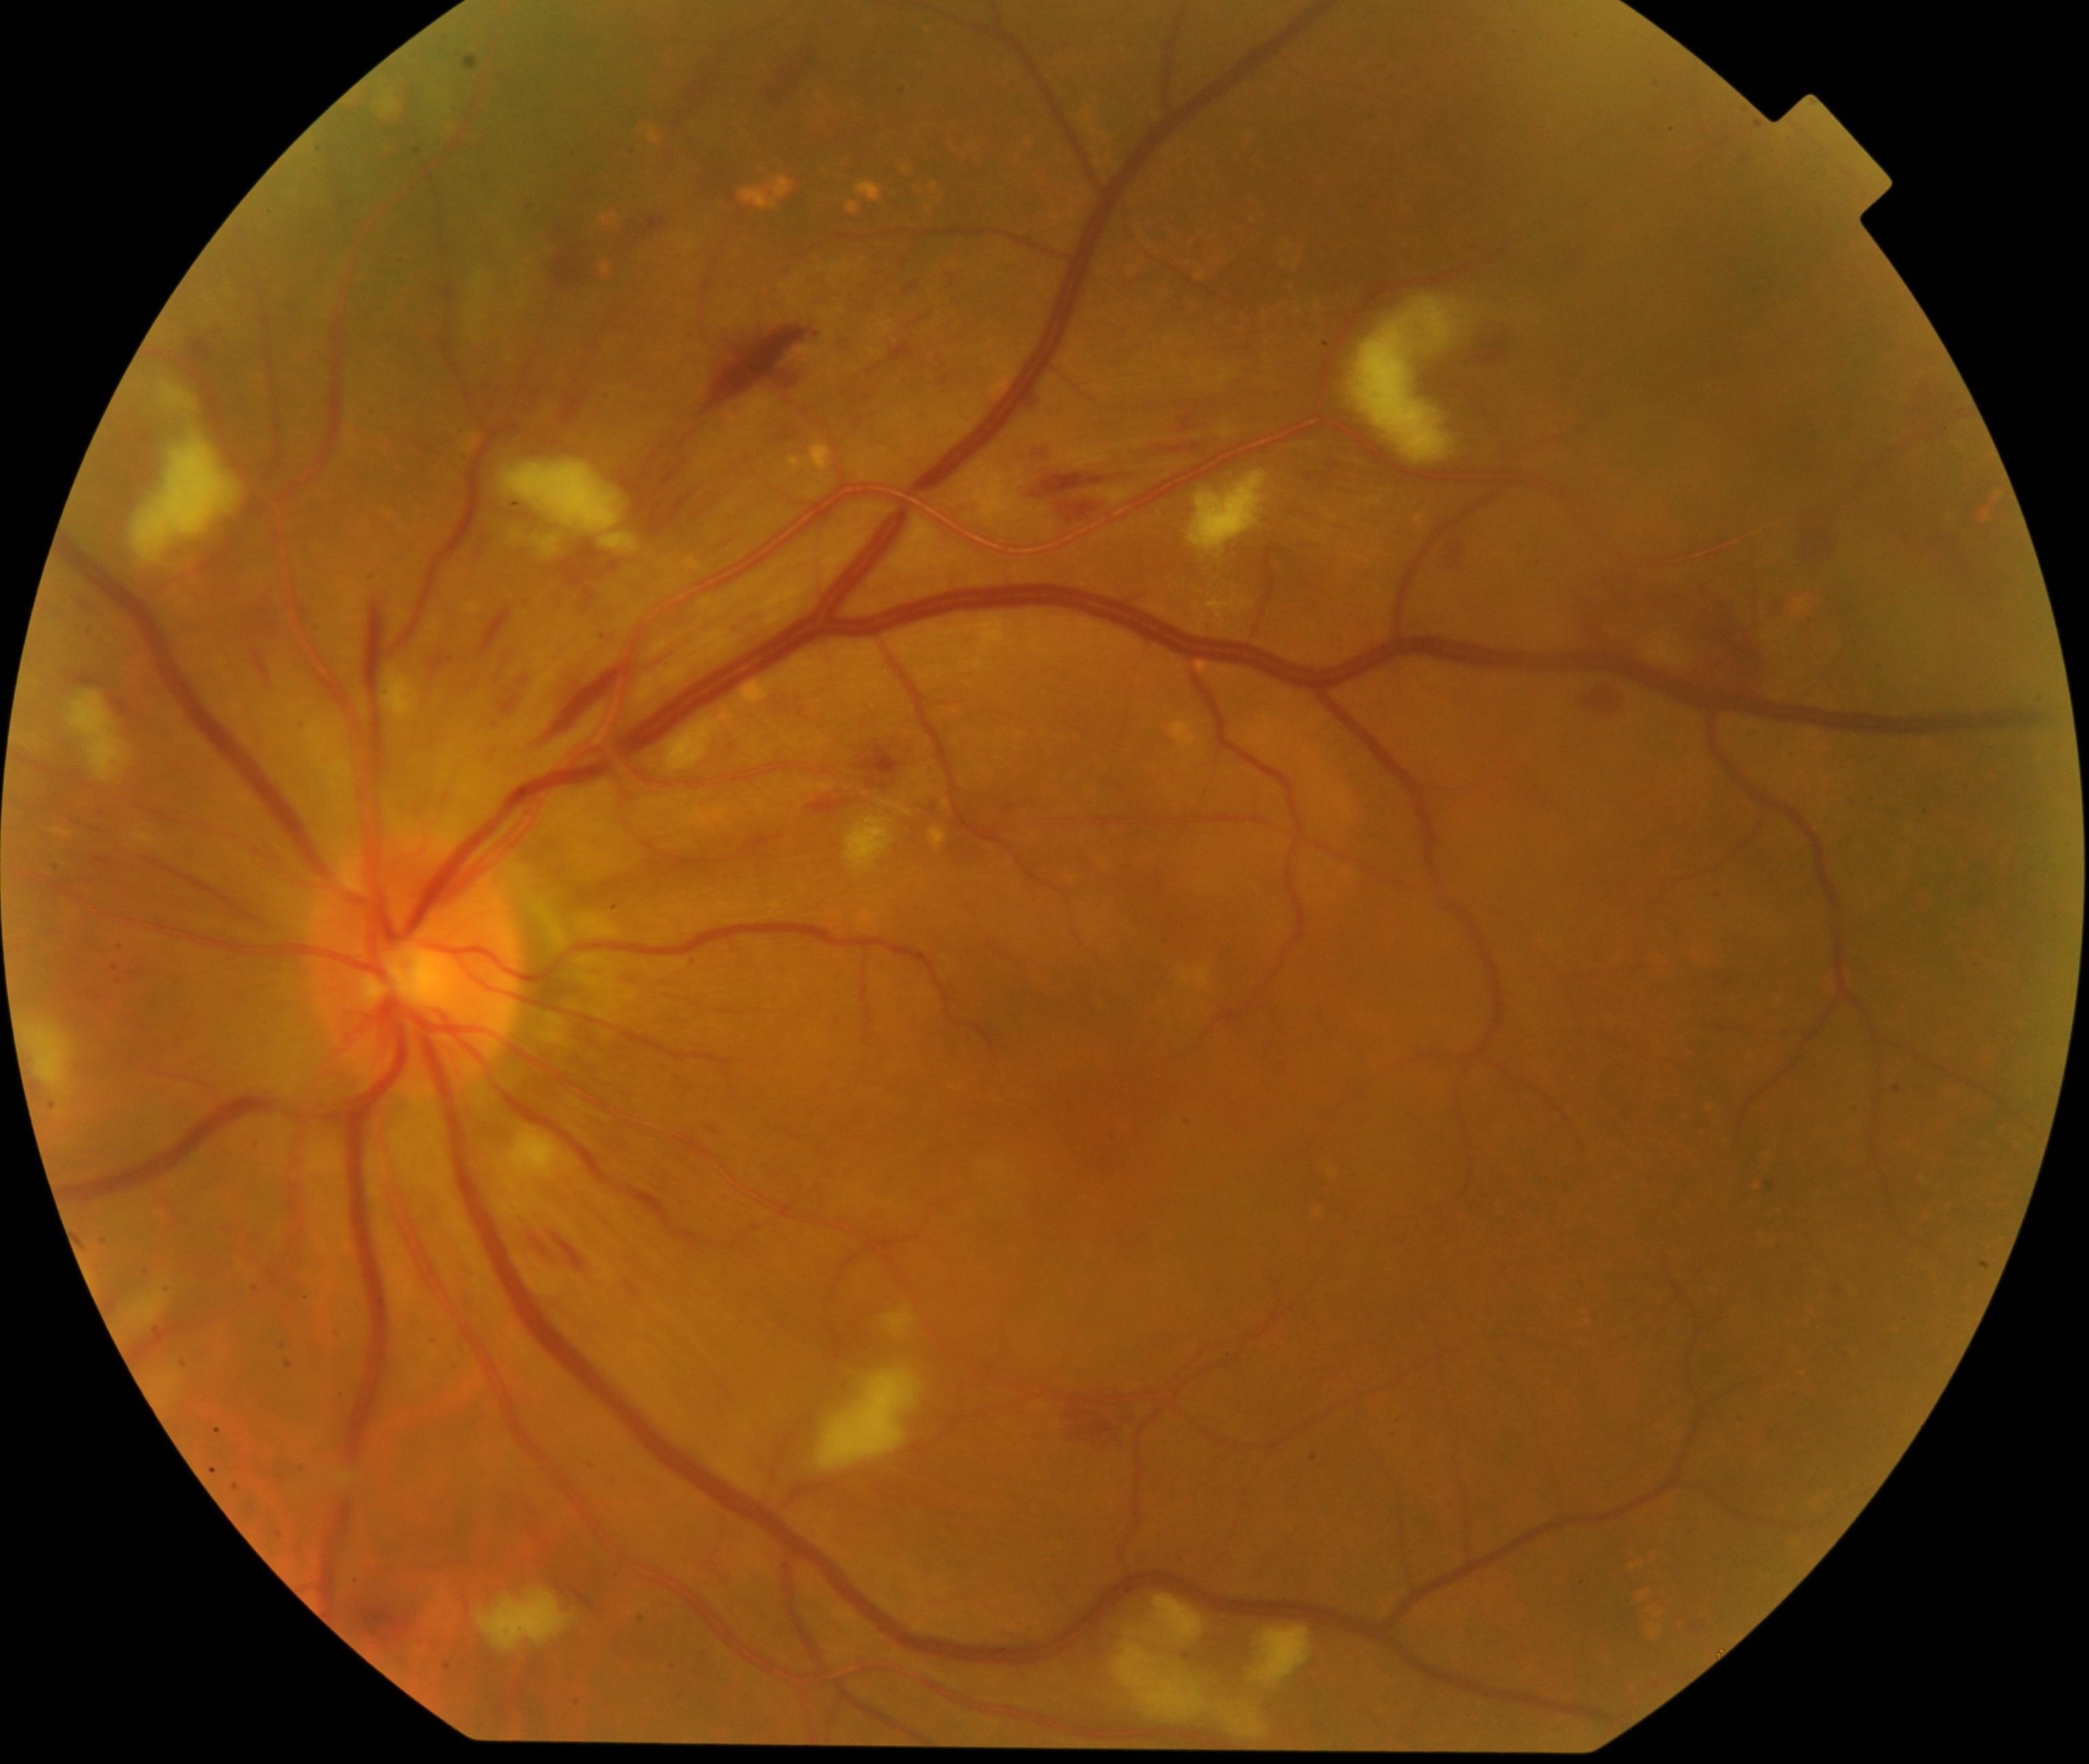 Impression: severe hypertensive retinopathy.